Nonmydriatic · 848 by 848 pixels.
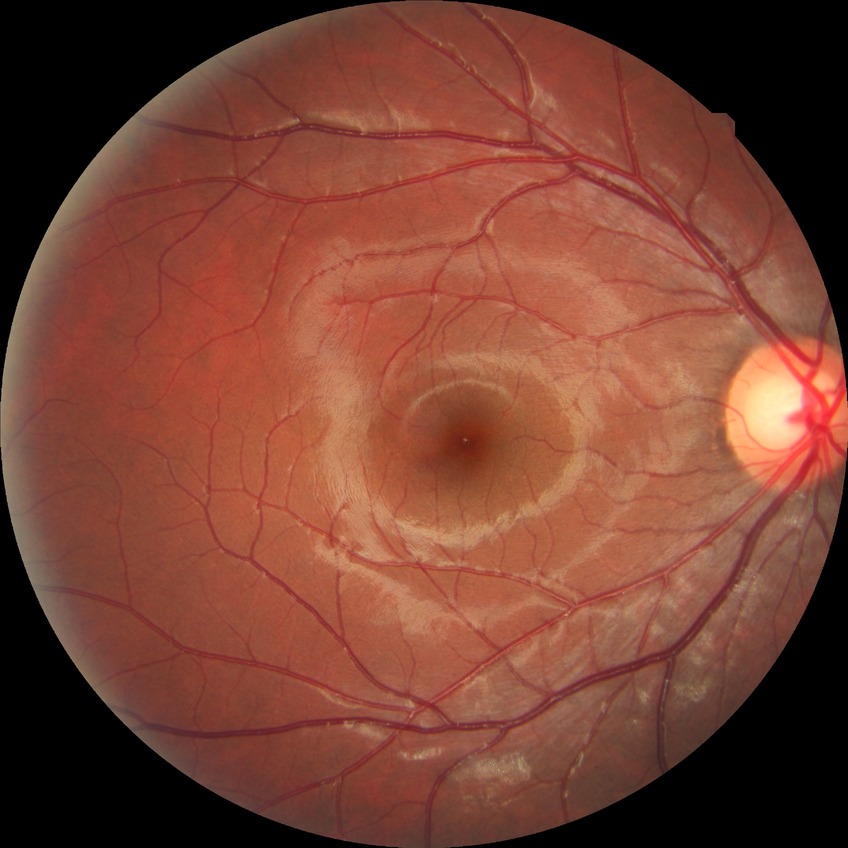

Diabetic retinopathy severity is no diabetic retinopathy.